Pediatric retinal photograph (wide-field) — 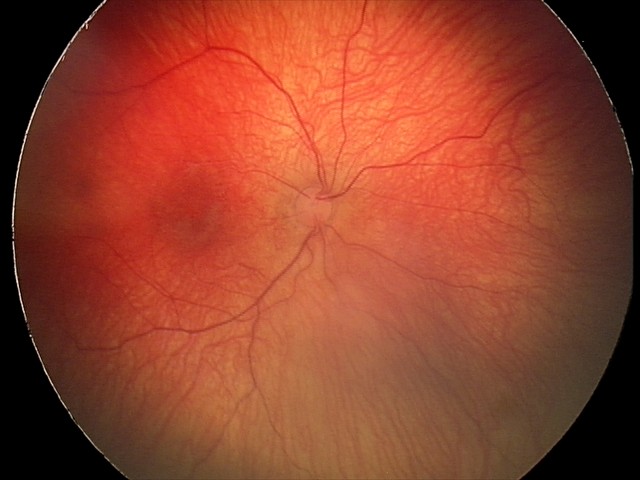

Assessment: no plus disease; status post retinopathy of prematurity.